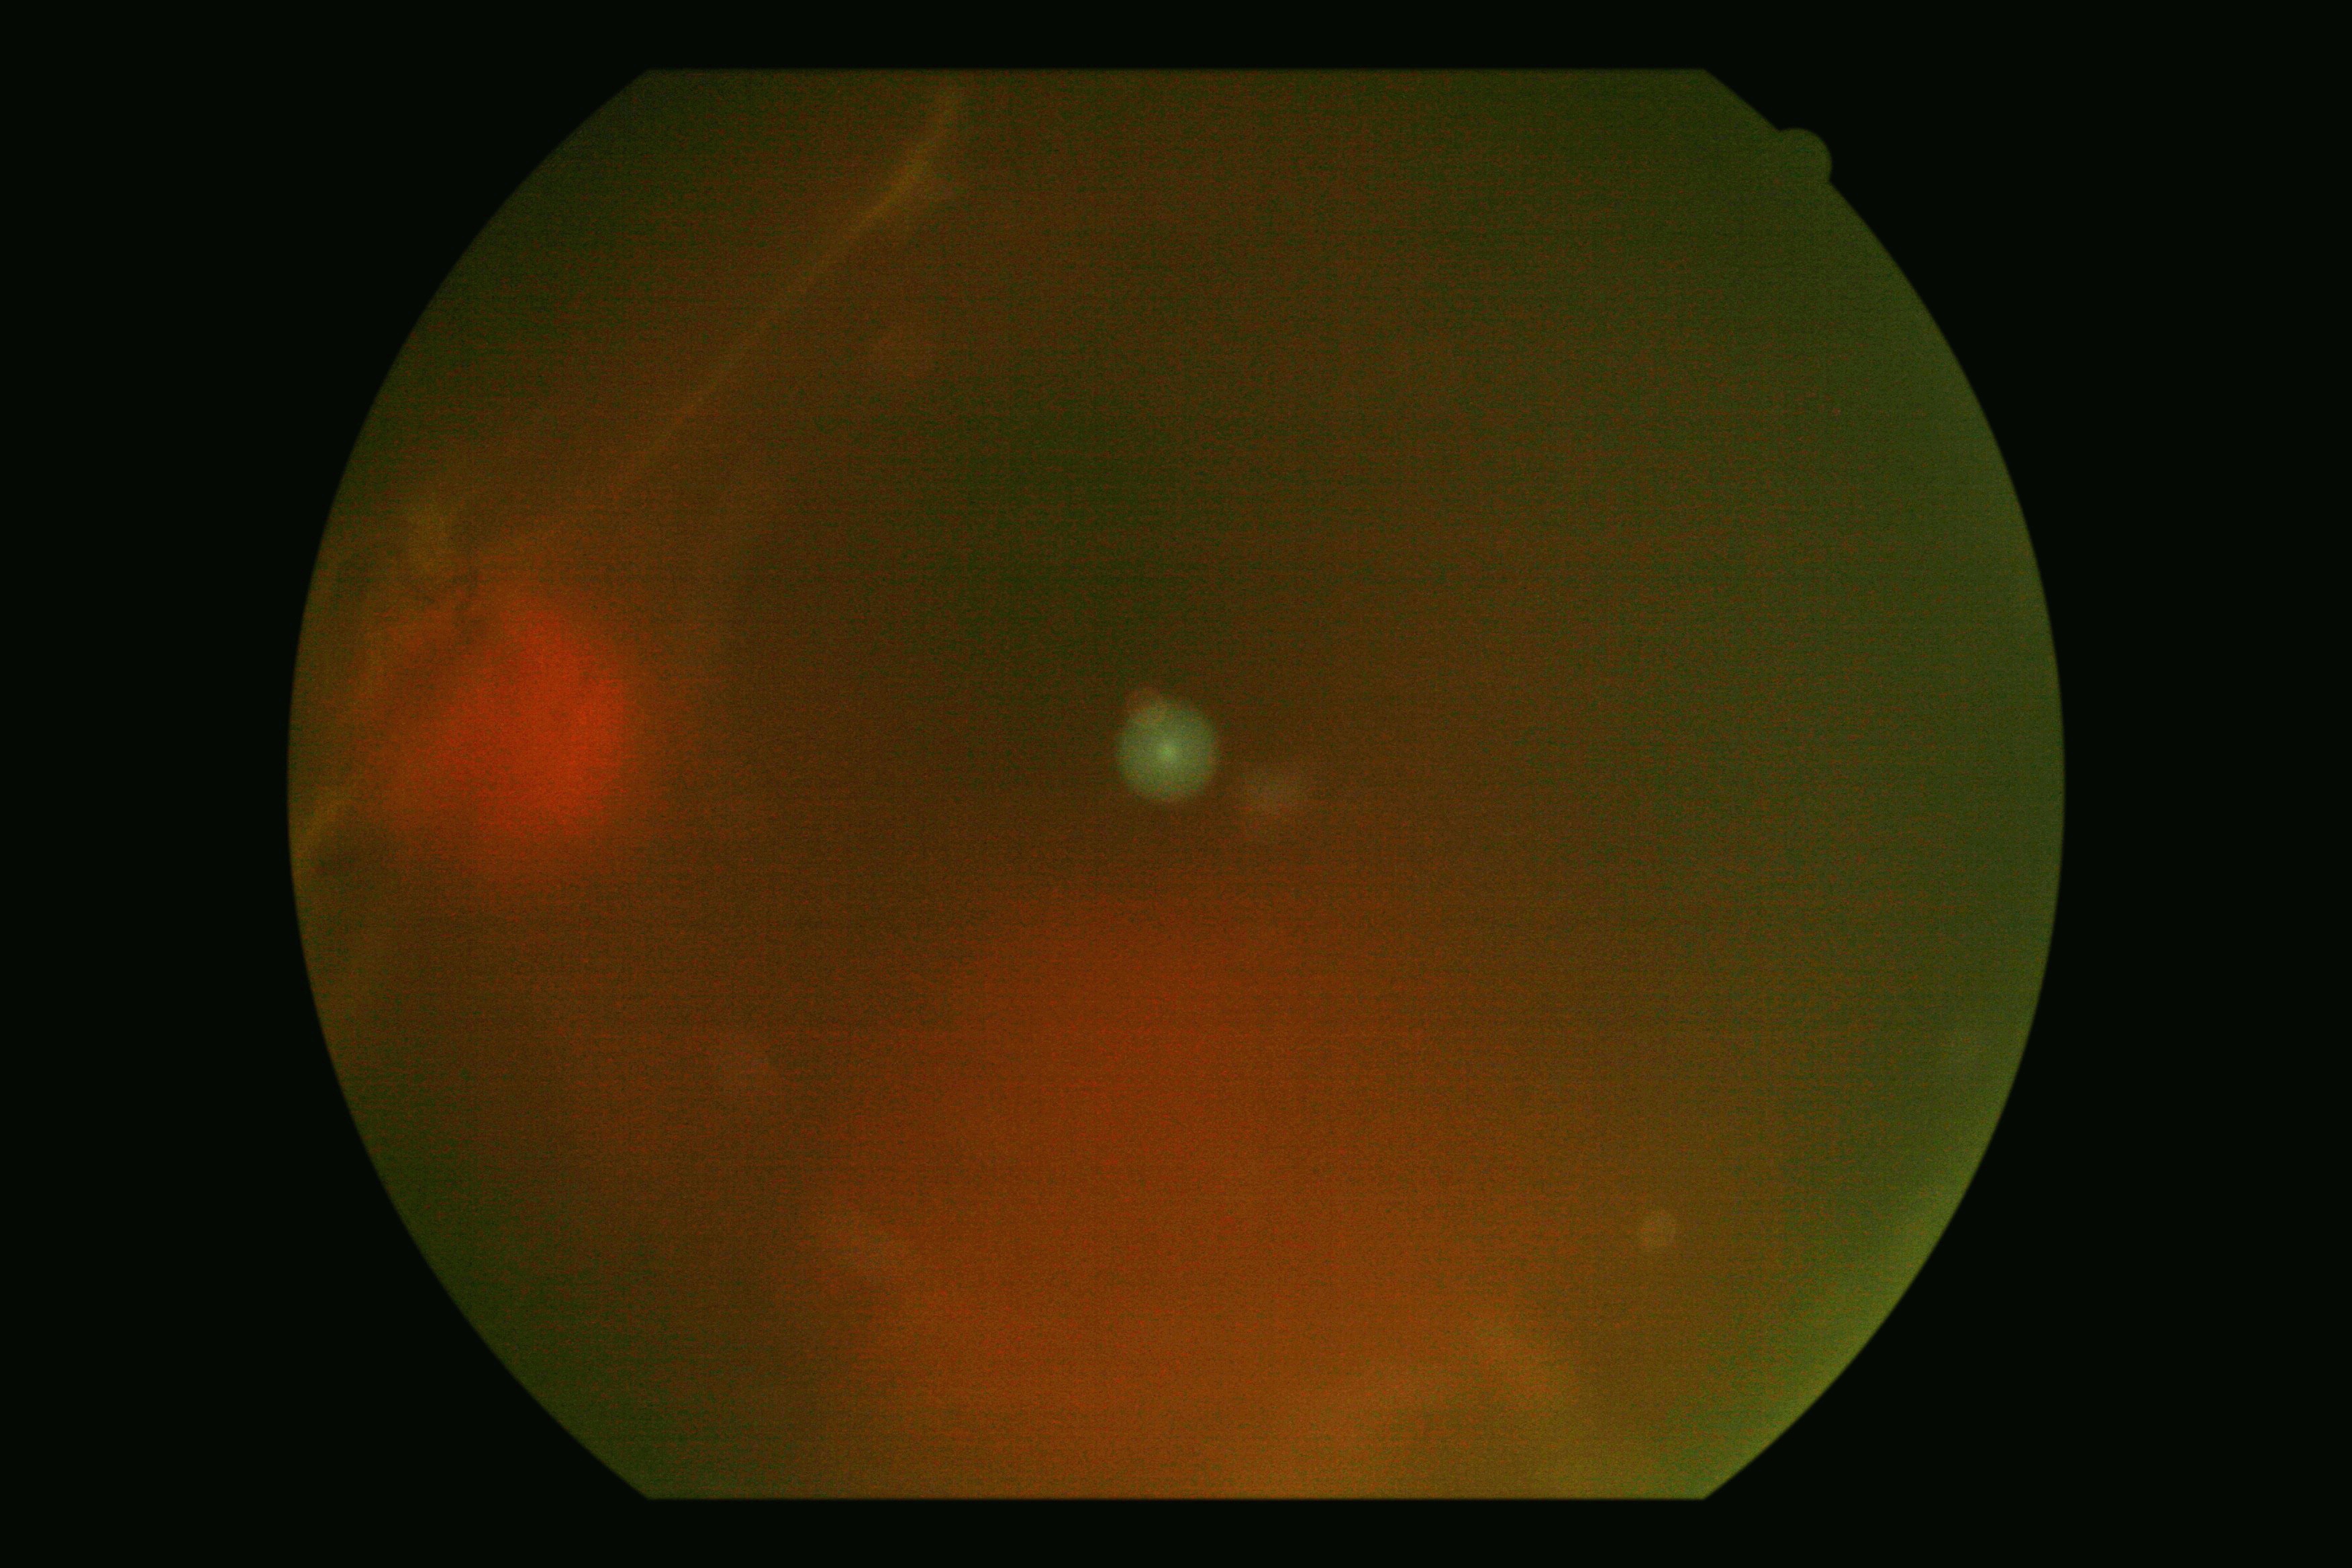 Retinopathy grade: 4 (PDR).
The retinopathy is classified as proliferative diabetic retinopathy.